45-degree field of view — 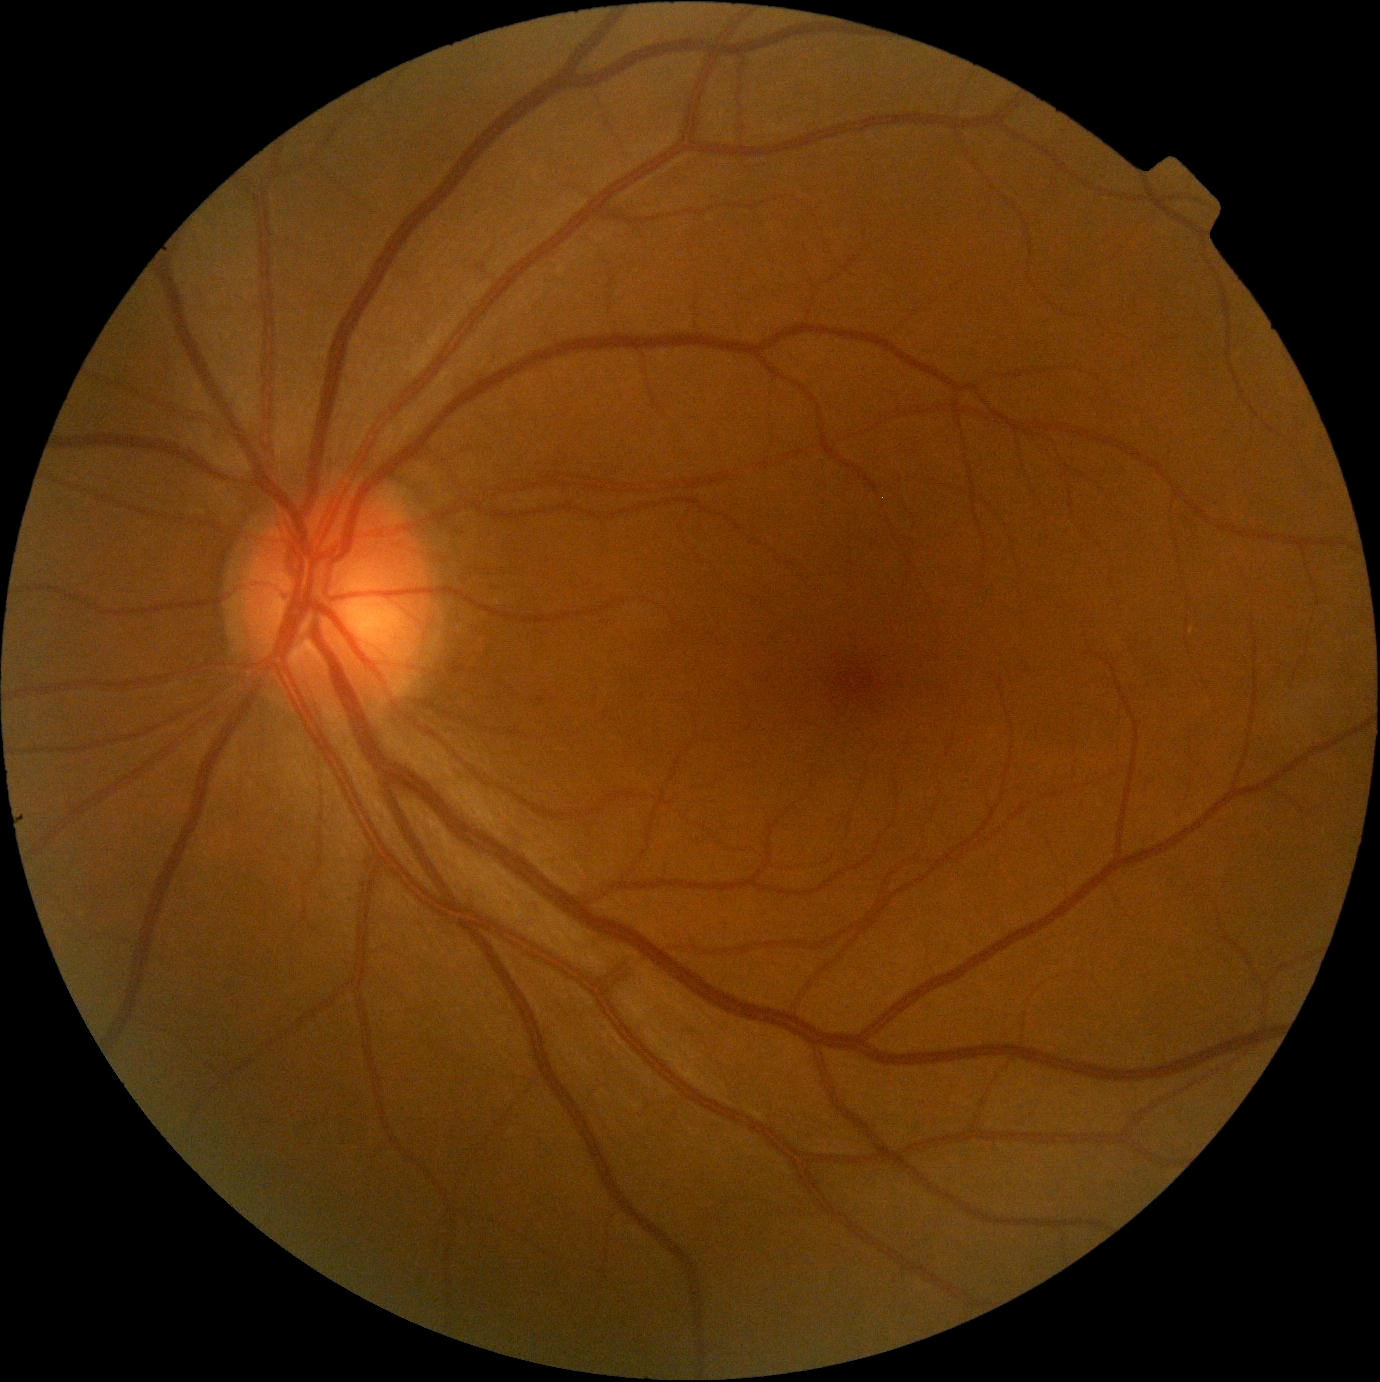
Diabetic retinopathy severity is no apparent diabetic retinopathy (grade 0).